Nonmydriatic fundus photograph
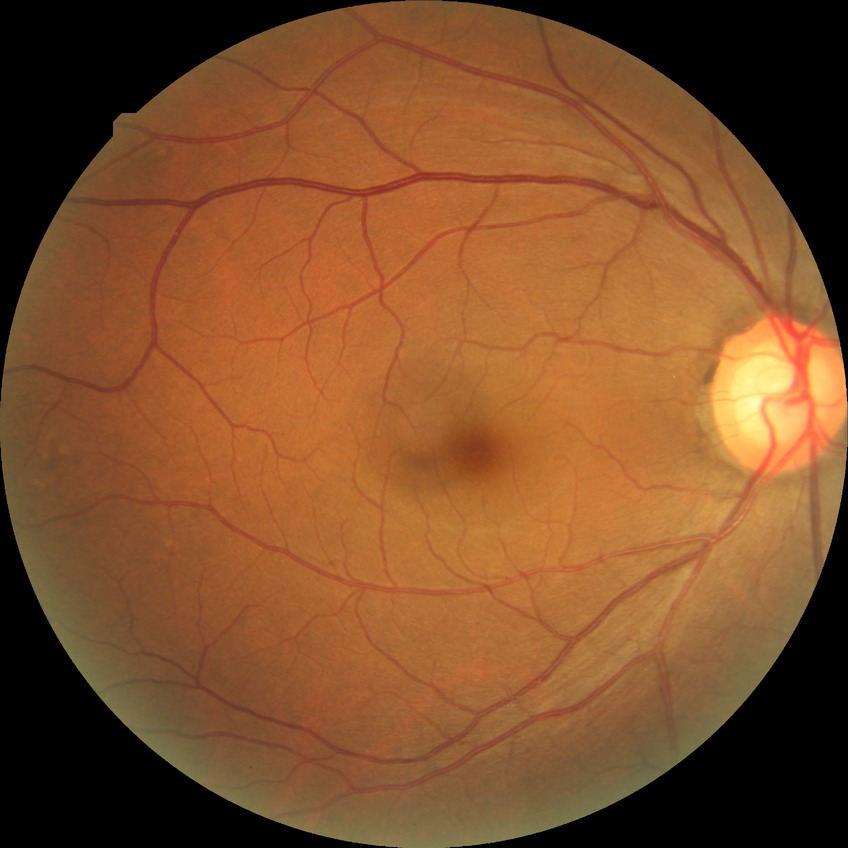
modified Davis grading = no diabetic retinopathy.